1932 by 1932 pixels, FOV: 45 degrees:
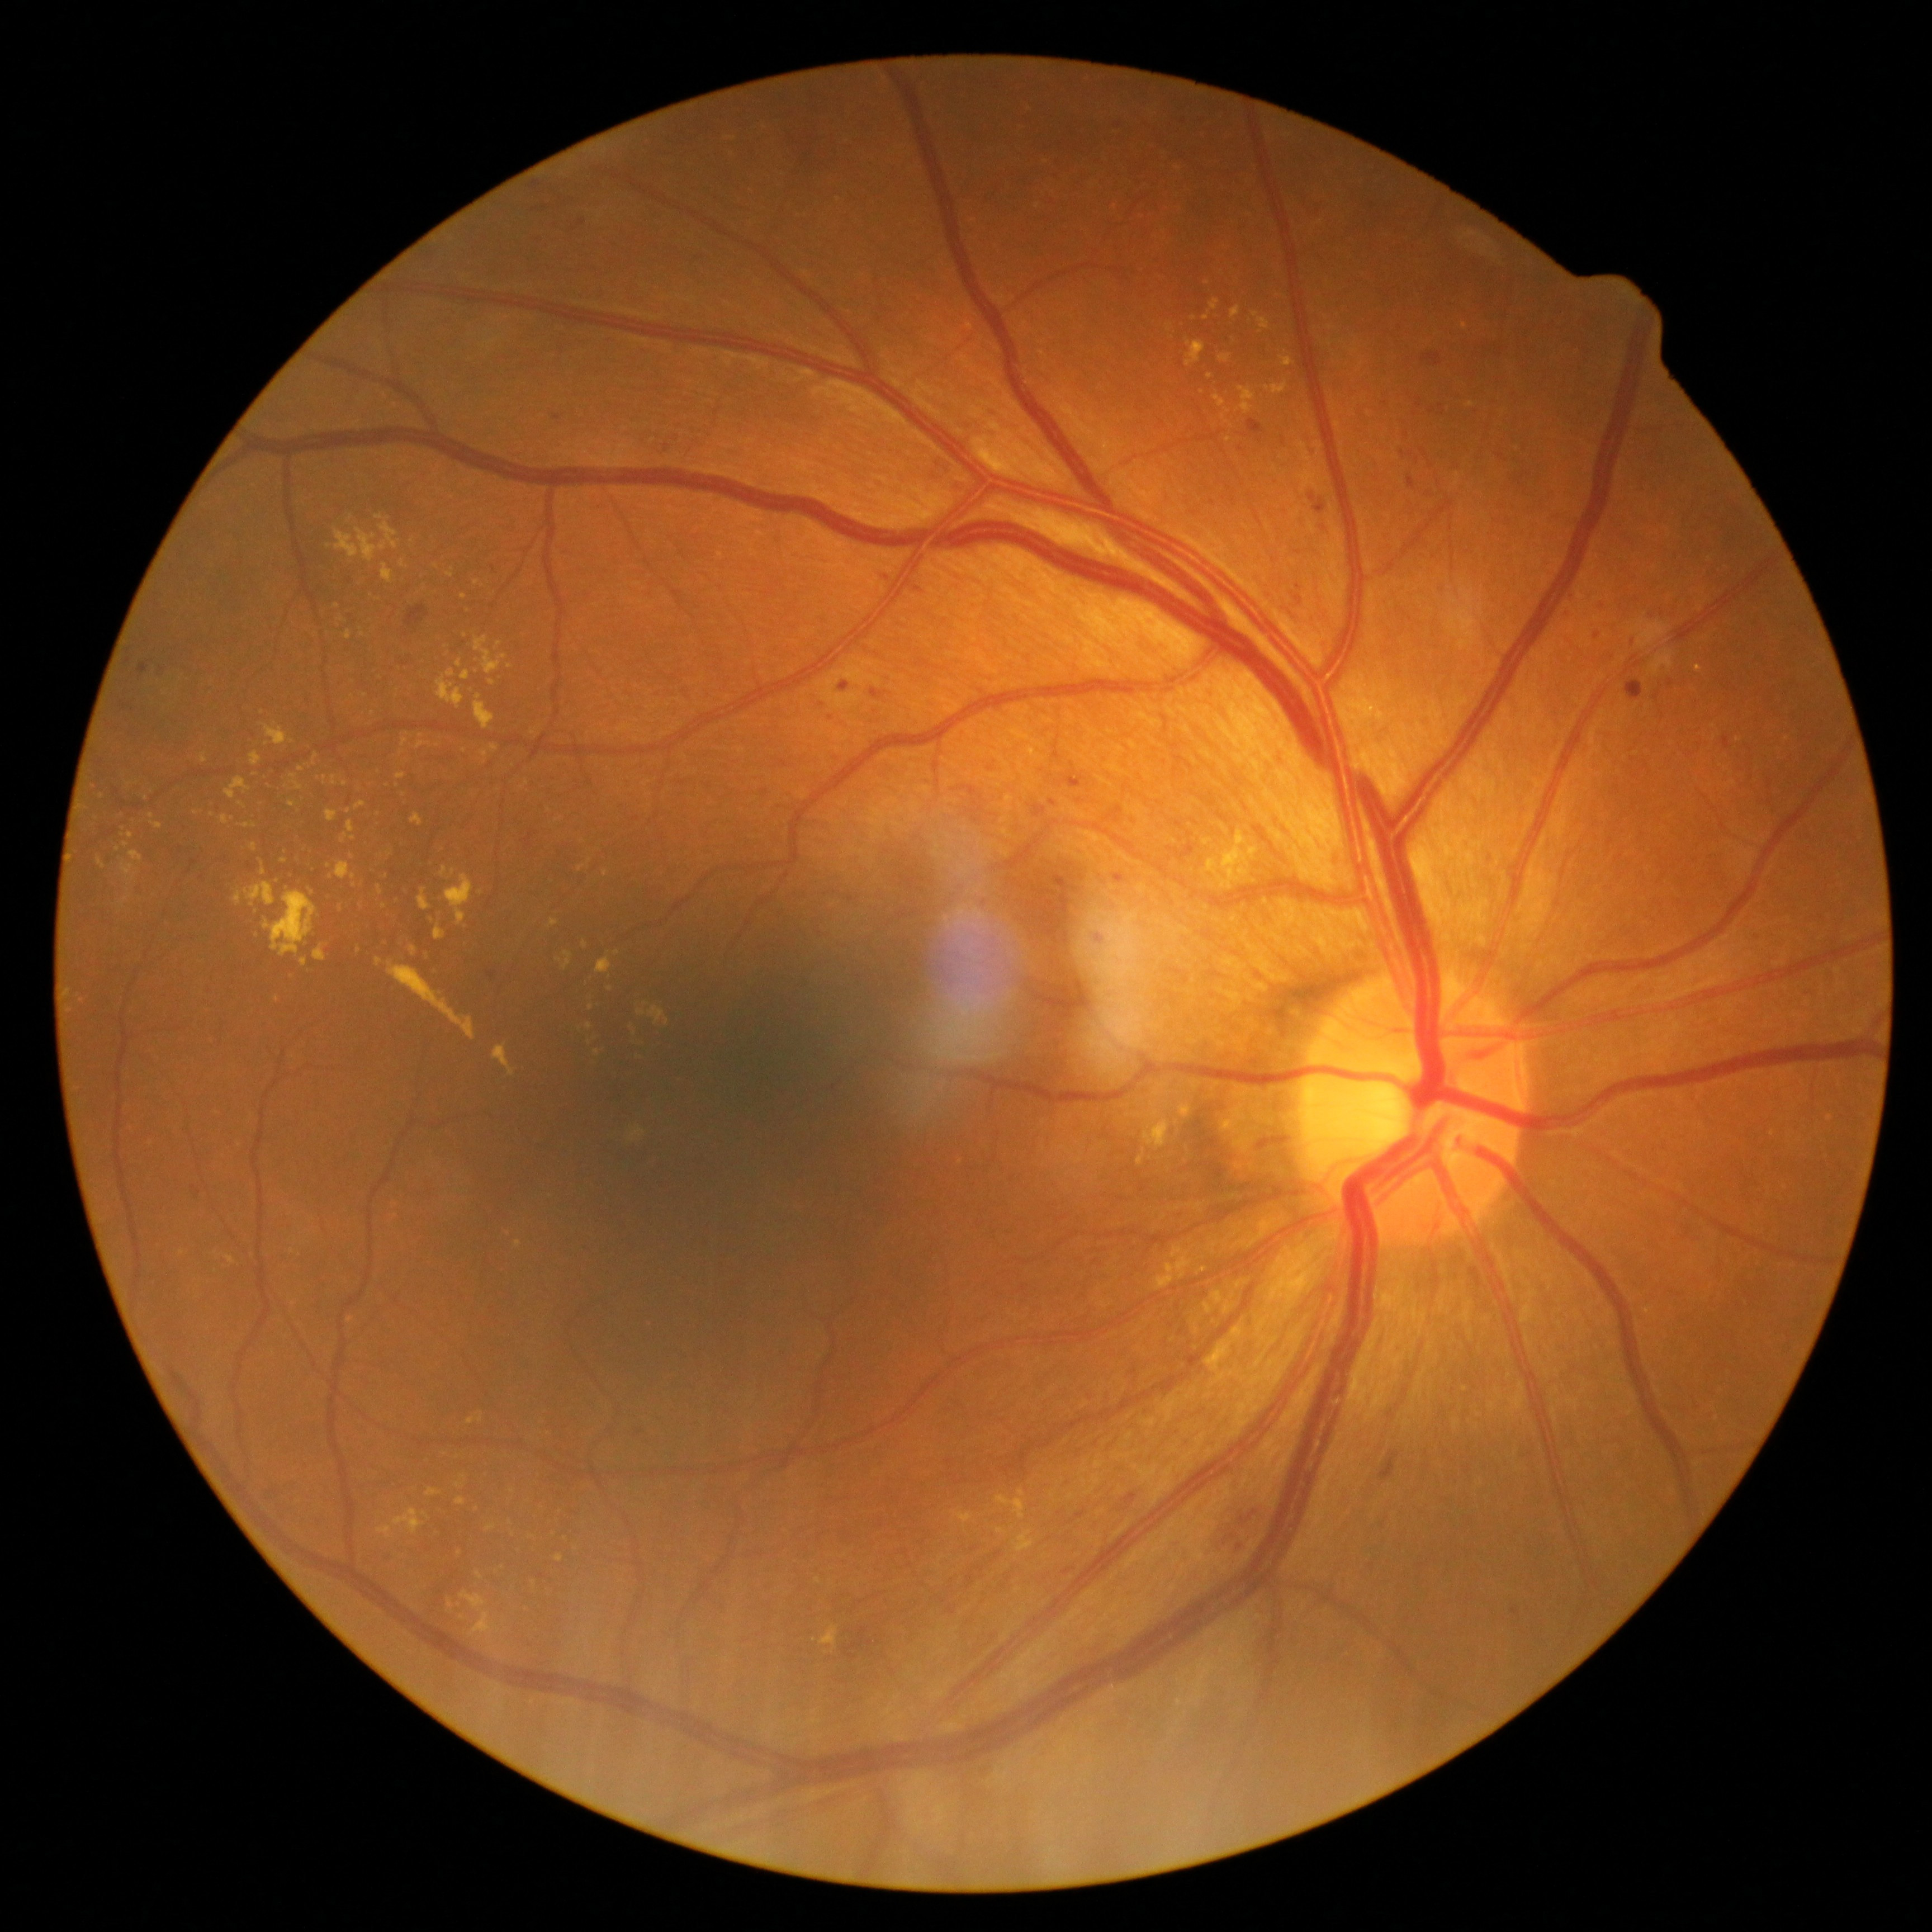
DR is grade 2 (moderate NPDR)
Representative lesions:
- EXs (continued): 1266:382:1287:395; 356:946:362:954; 335:515:397:562; 1230:307:1242:319; 1157:1262:1201:1281; 234:889:241:905; 495:641:501:650; 423:1511:430:1519; 263:725:288:745; 300:958:308:967; 486:1523:497:1531; 291:774:304:790
- Small EXs near 492/683; 527/783; 637/740; 511/1523; 476/582; 1202/393; 453/874; 464/751